Camera: Natus RetCam Envision (130° FOV) · RetCam wide-field infant fundus image — 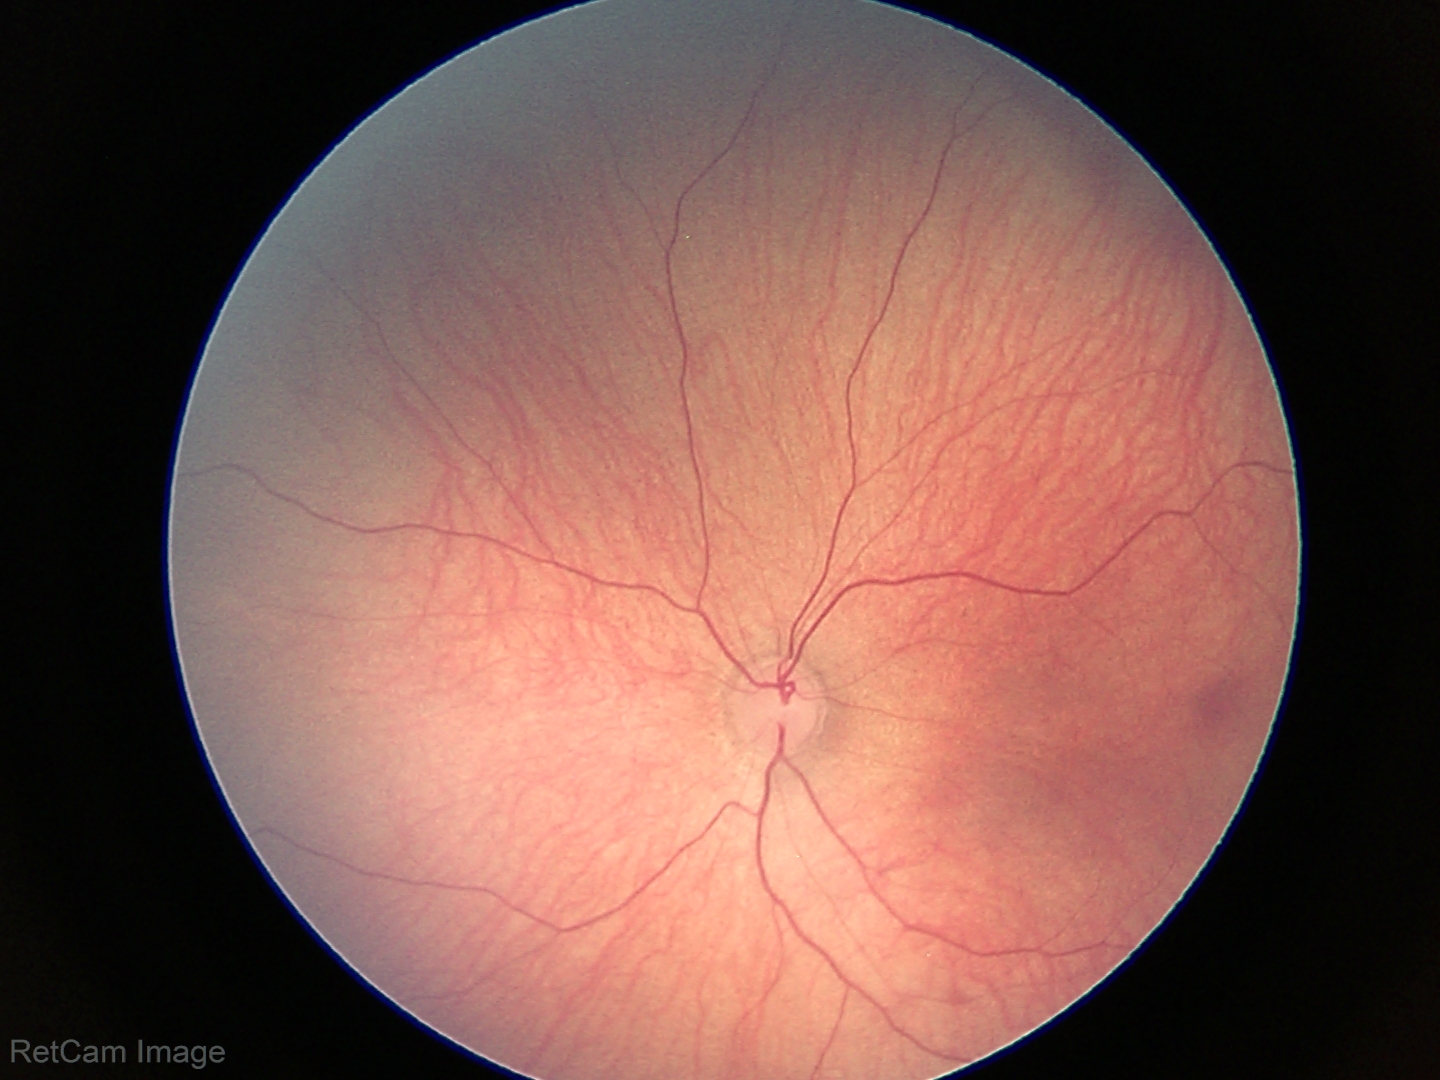
Physiological retinal appearance for postconceptual age.